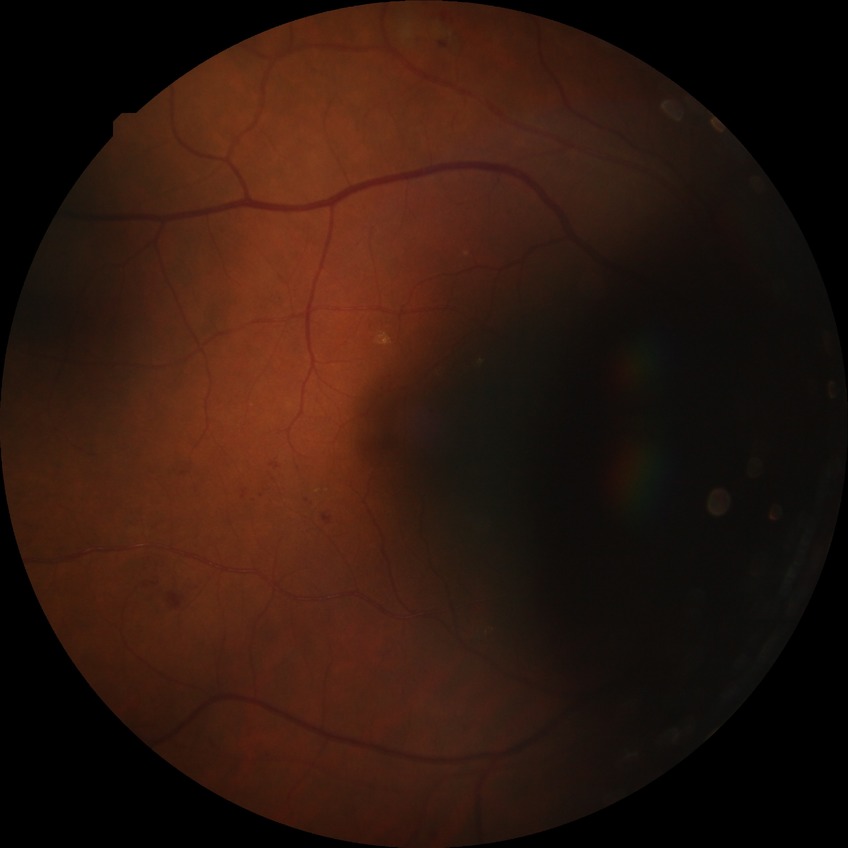   proliferative_class: non-proliferative diabetic retinopathy
  davis_grade: SDR (simple diabetic retinopathy)